Infant wide-field retinal image · 1240 x 1240 pixels.
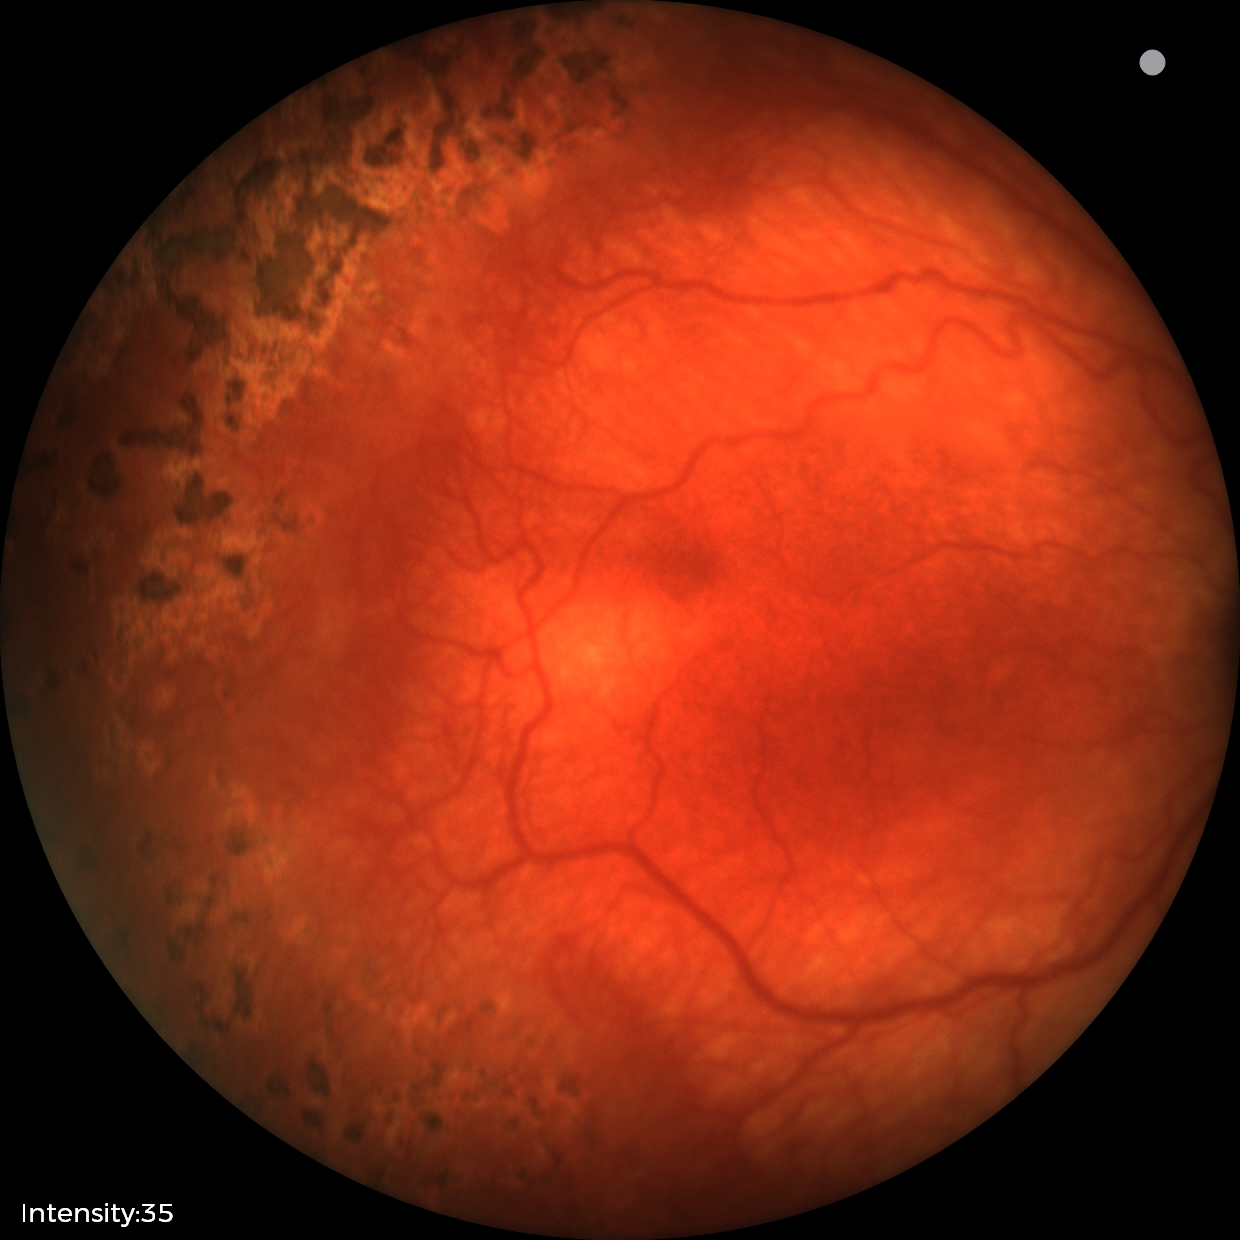
Series diagnosed as ROP stage 1.
Plus disease was diagnosed.